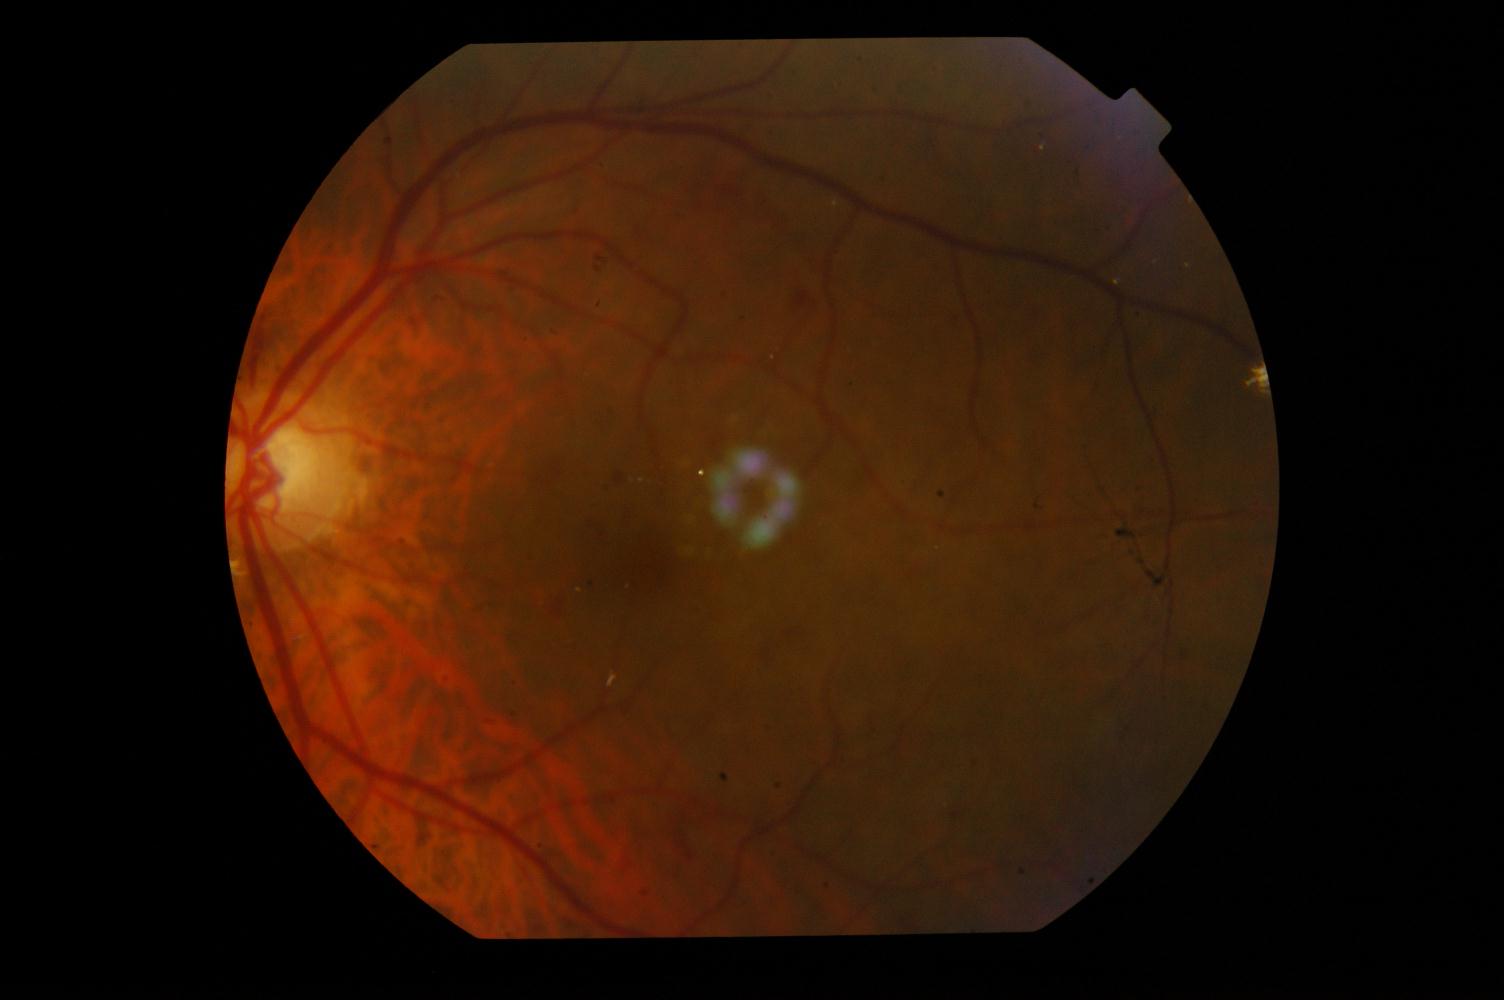

Diagnoses: diabetic retinopathy.